Infant wide-field retinal image: 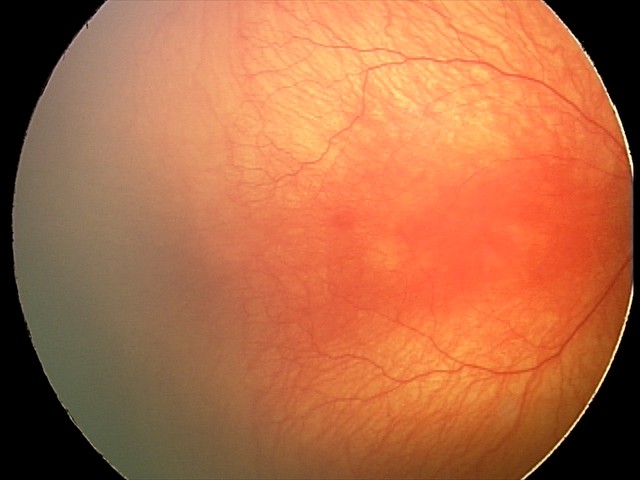 Screening diagnosis: A-ROP (aggressive ROP); plus disease.